Davis DR grading: 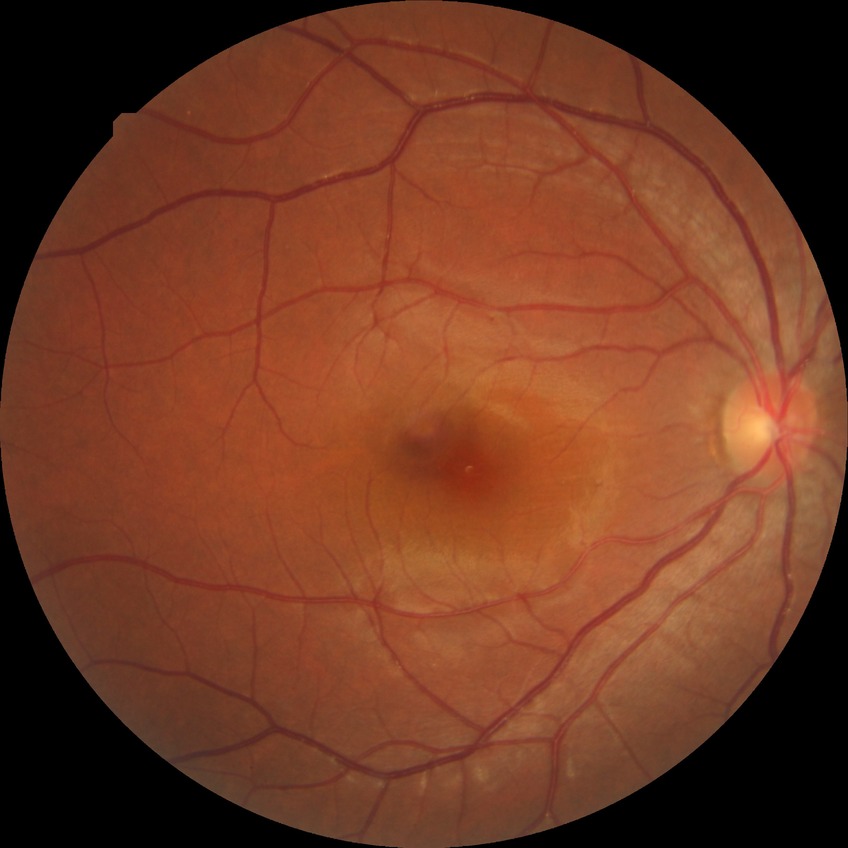
Diabetic retinopathy (DR): simple diabetic retinopathy (SDR).